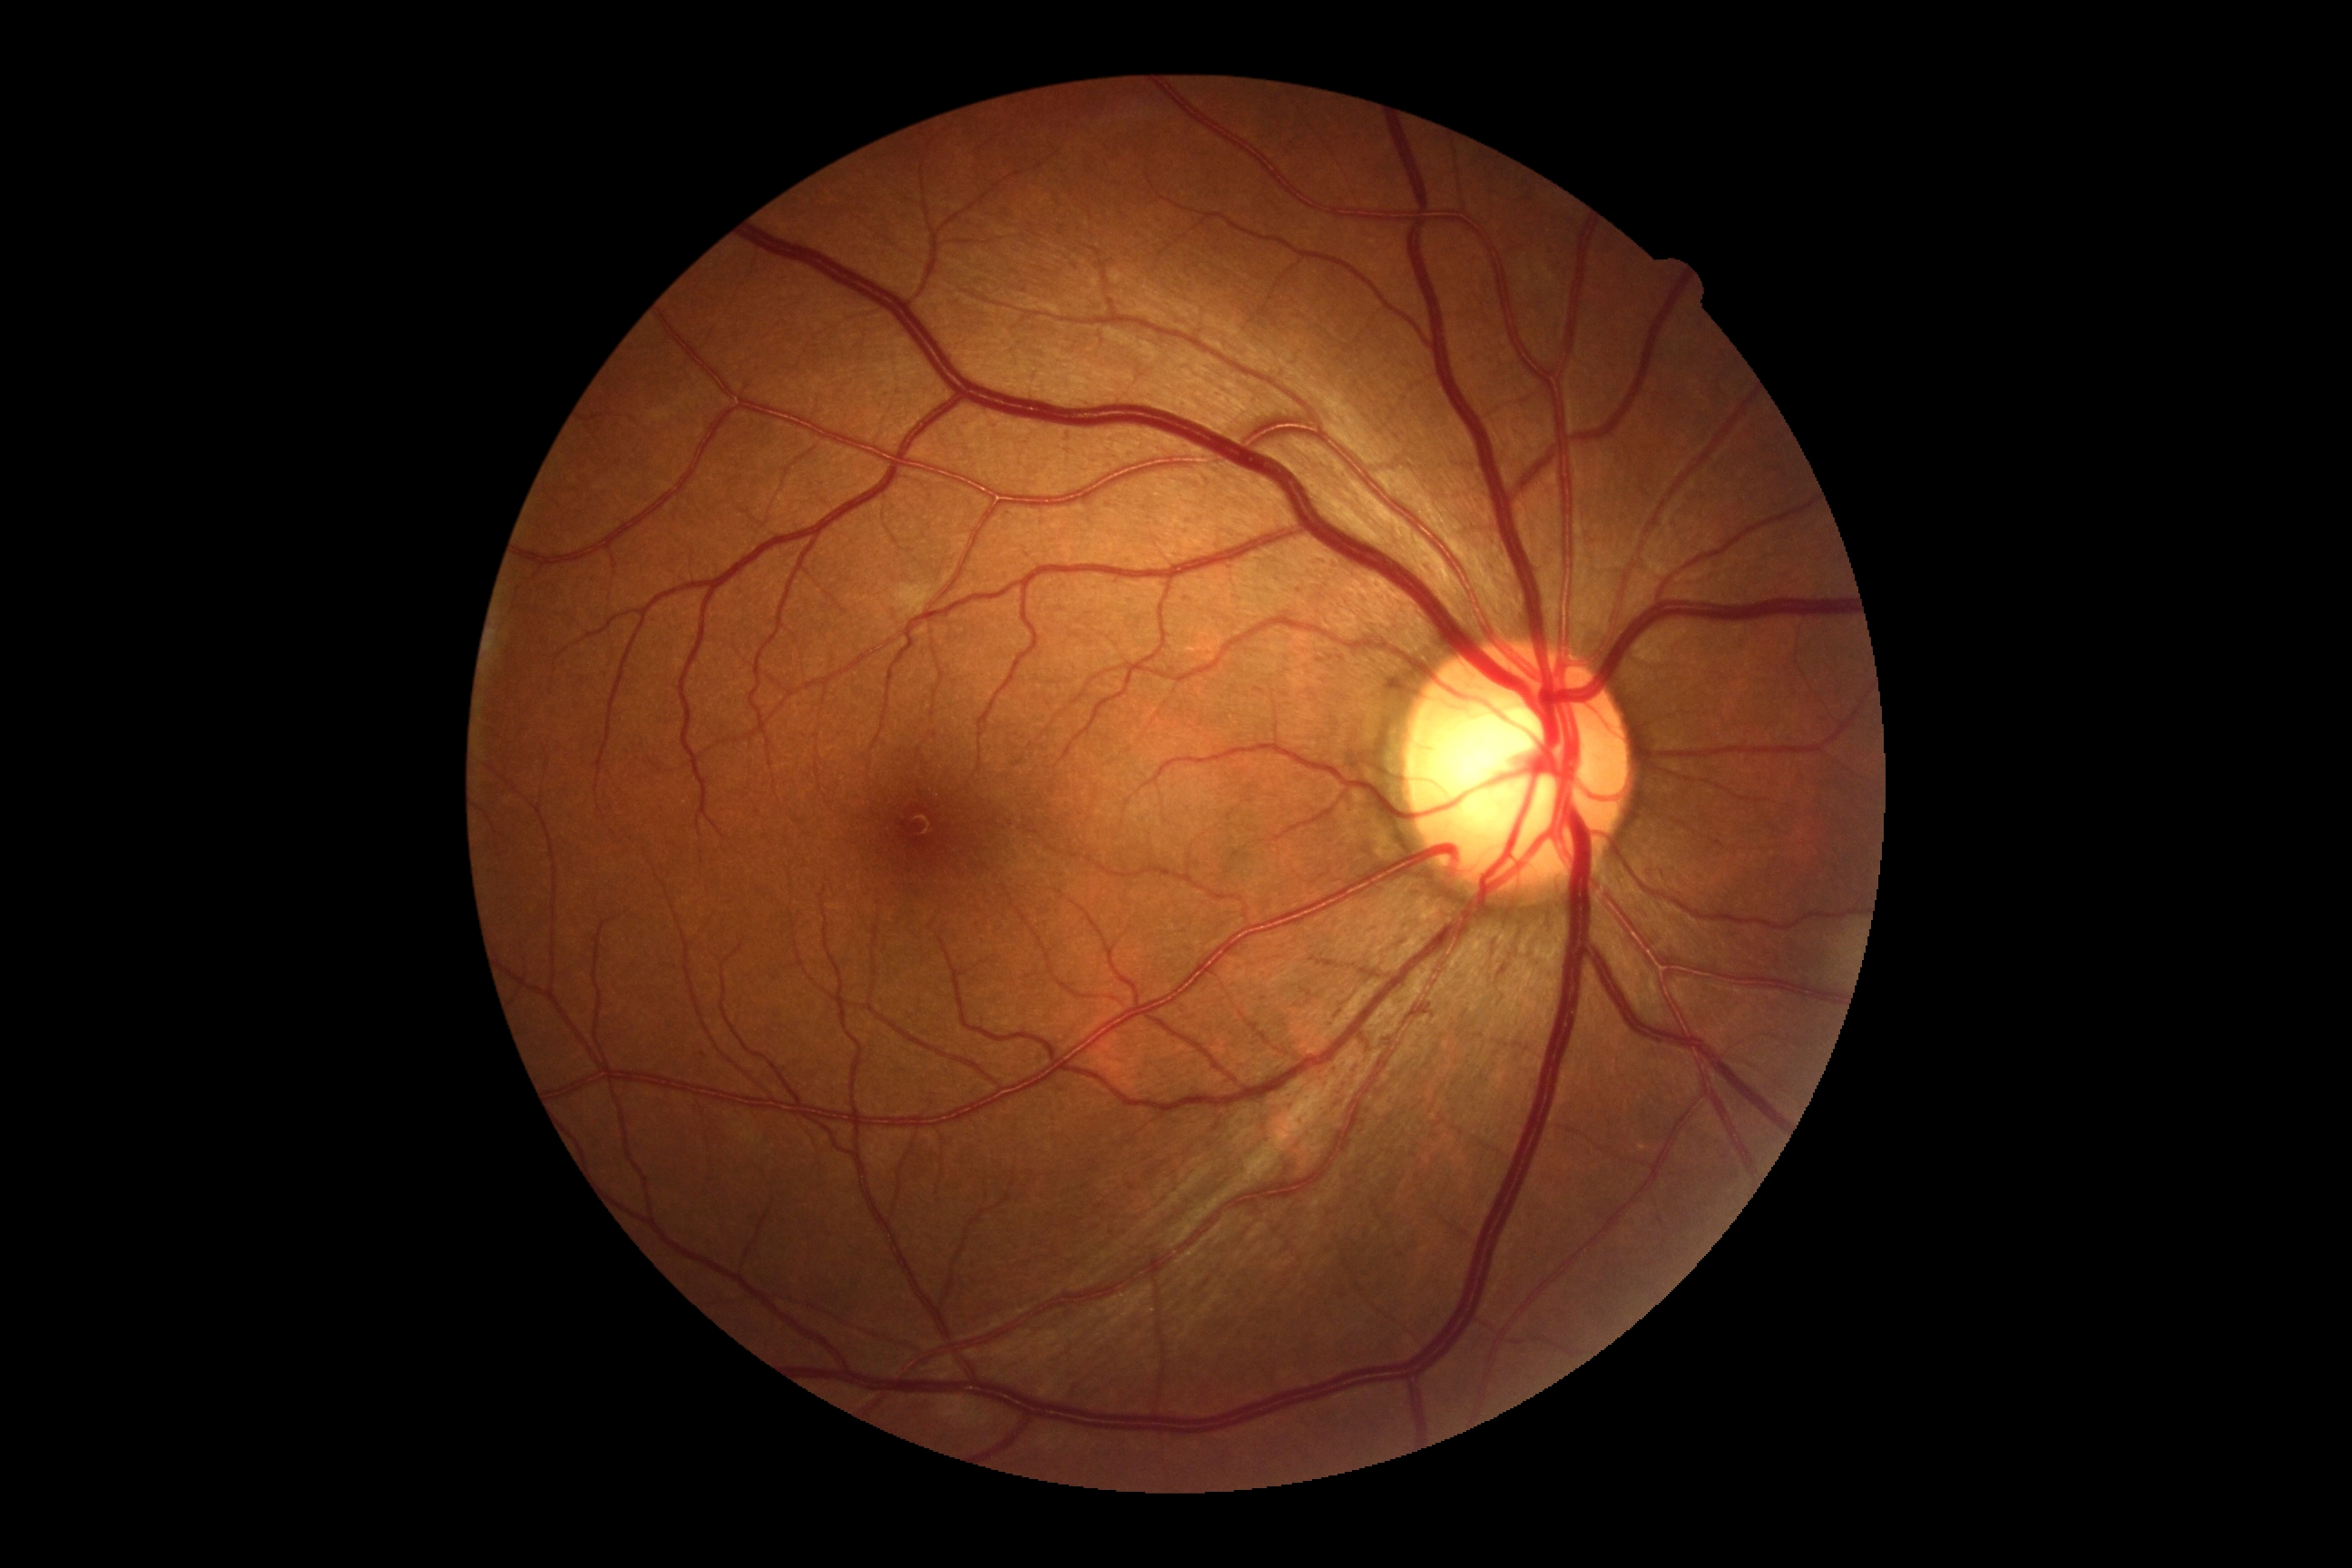
DR stage is grade 2 (moderate NPDR).